Graded on the modified Davis scale · NIDEK AFC-230:
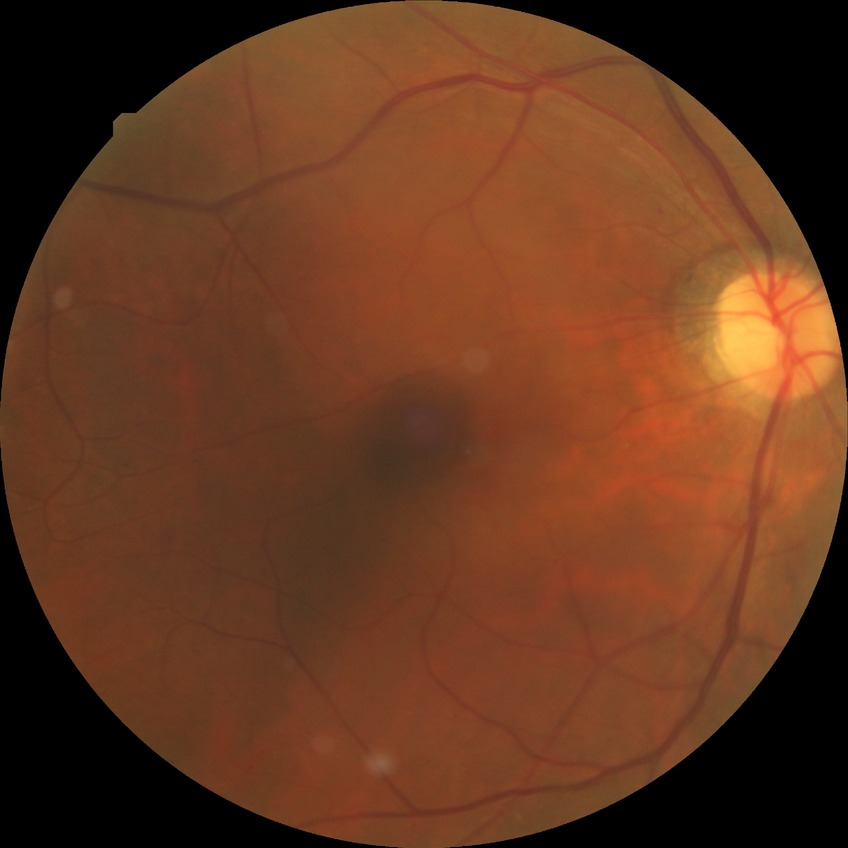 Modified Davis grading: simple diabetic retinopathy.